Wide-field retinal mosaic image
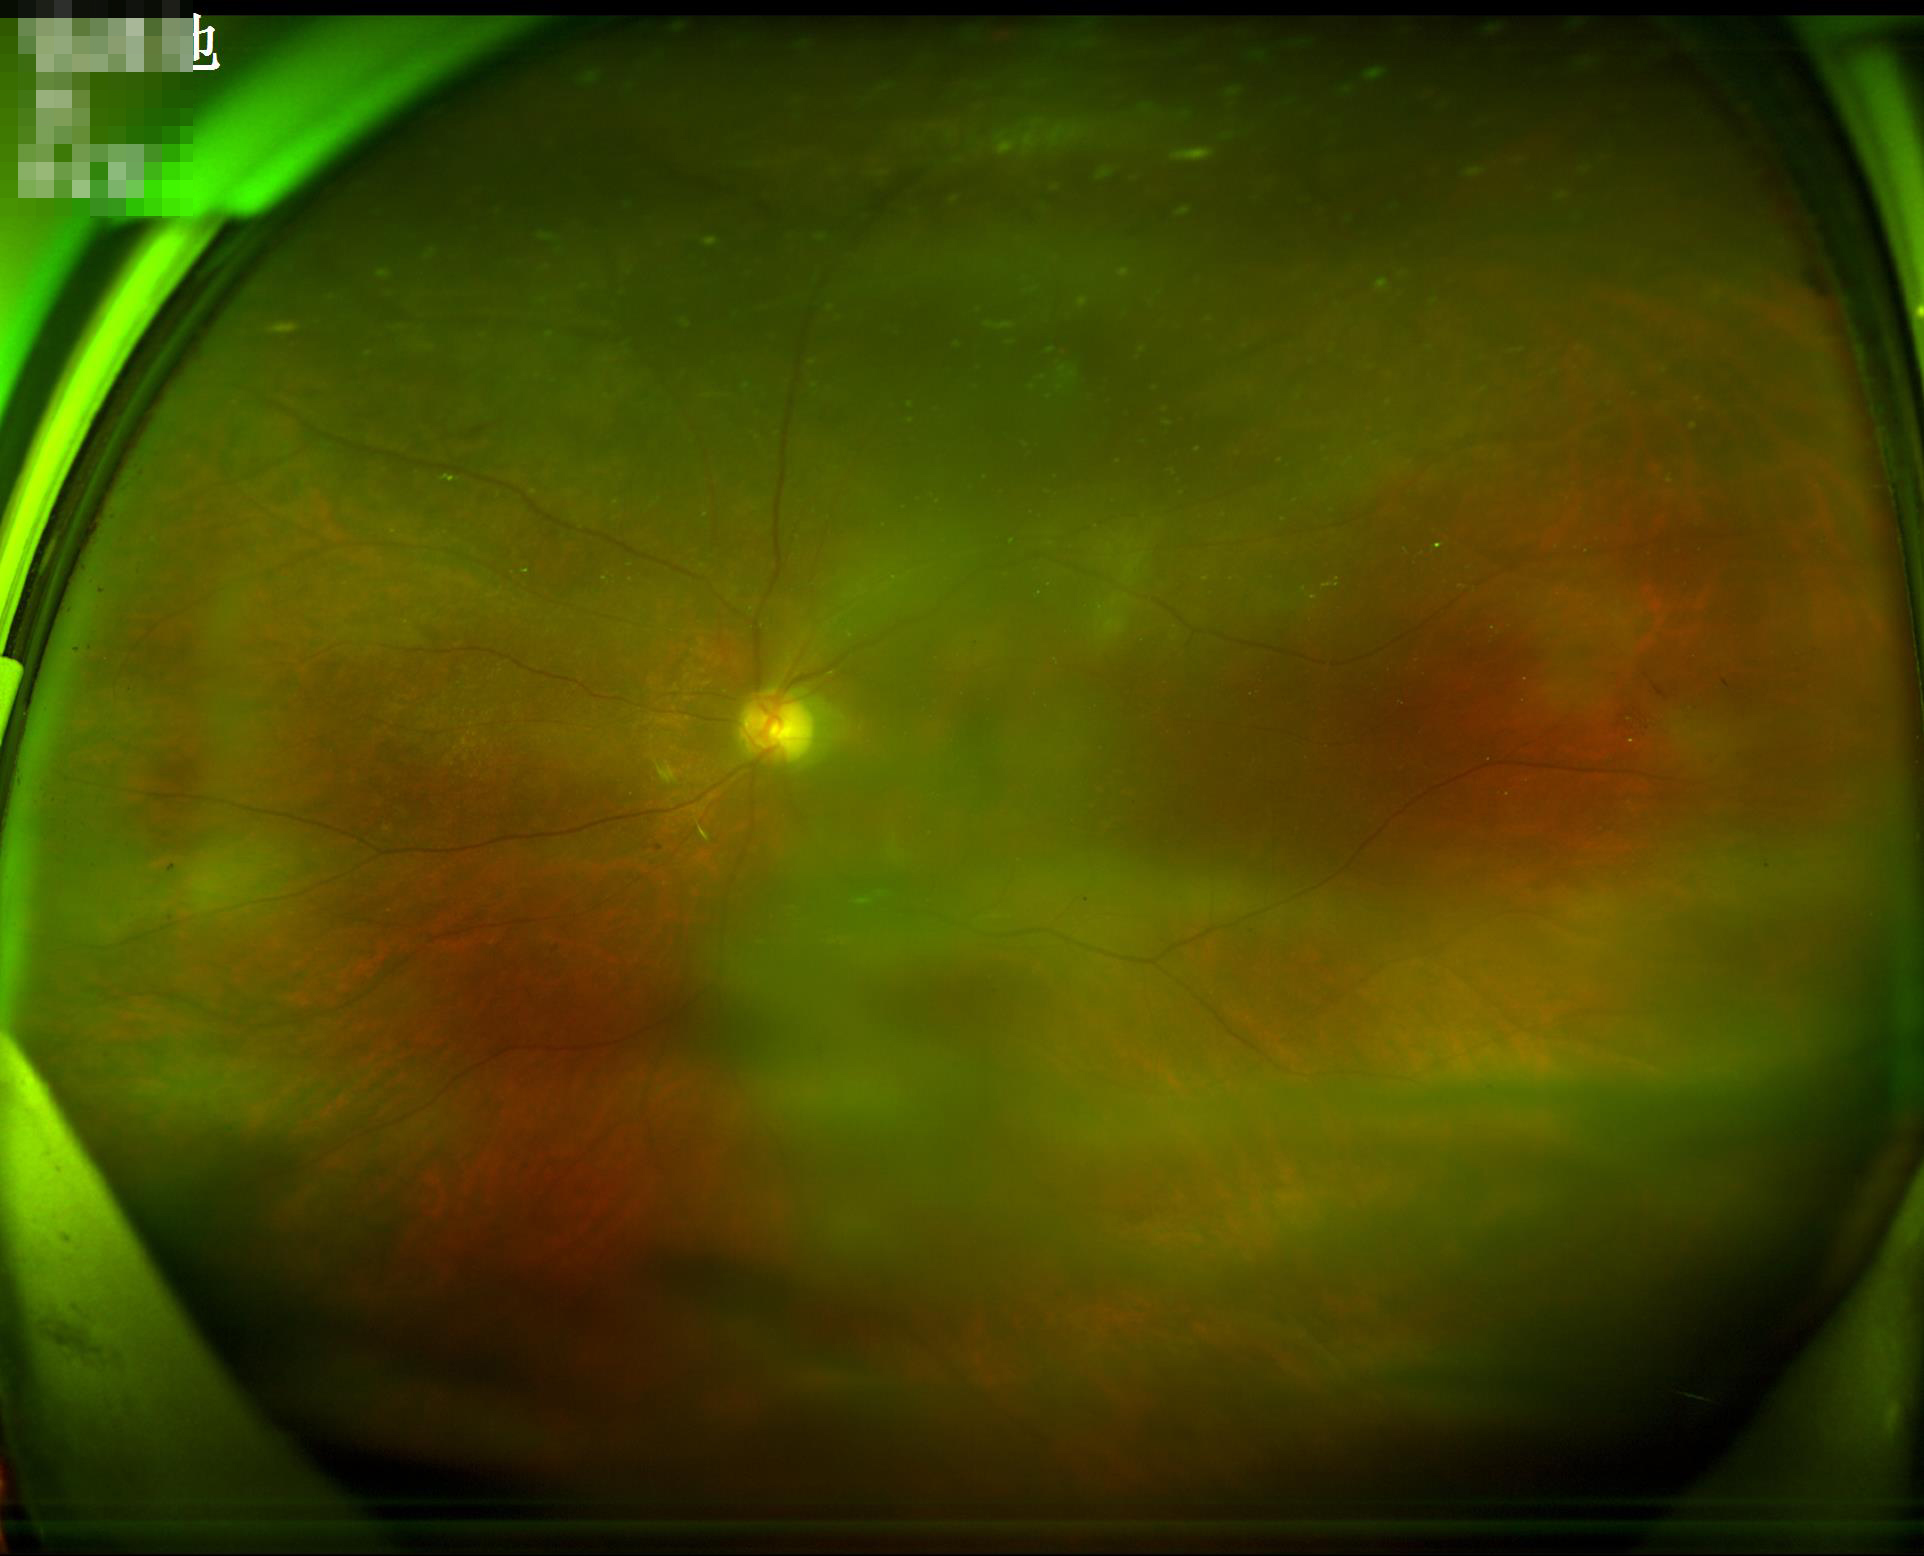

  overall_quality: low
  illumination: suboptimal
  contrast: satisfactory
  clarity: reduced